Color fundus photograph. 45° field of view. 2184x1690px:
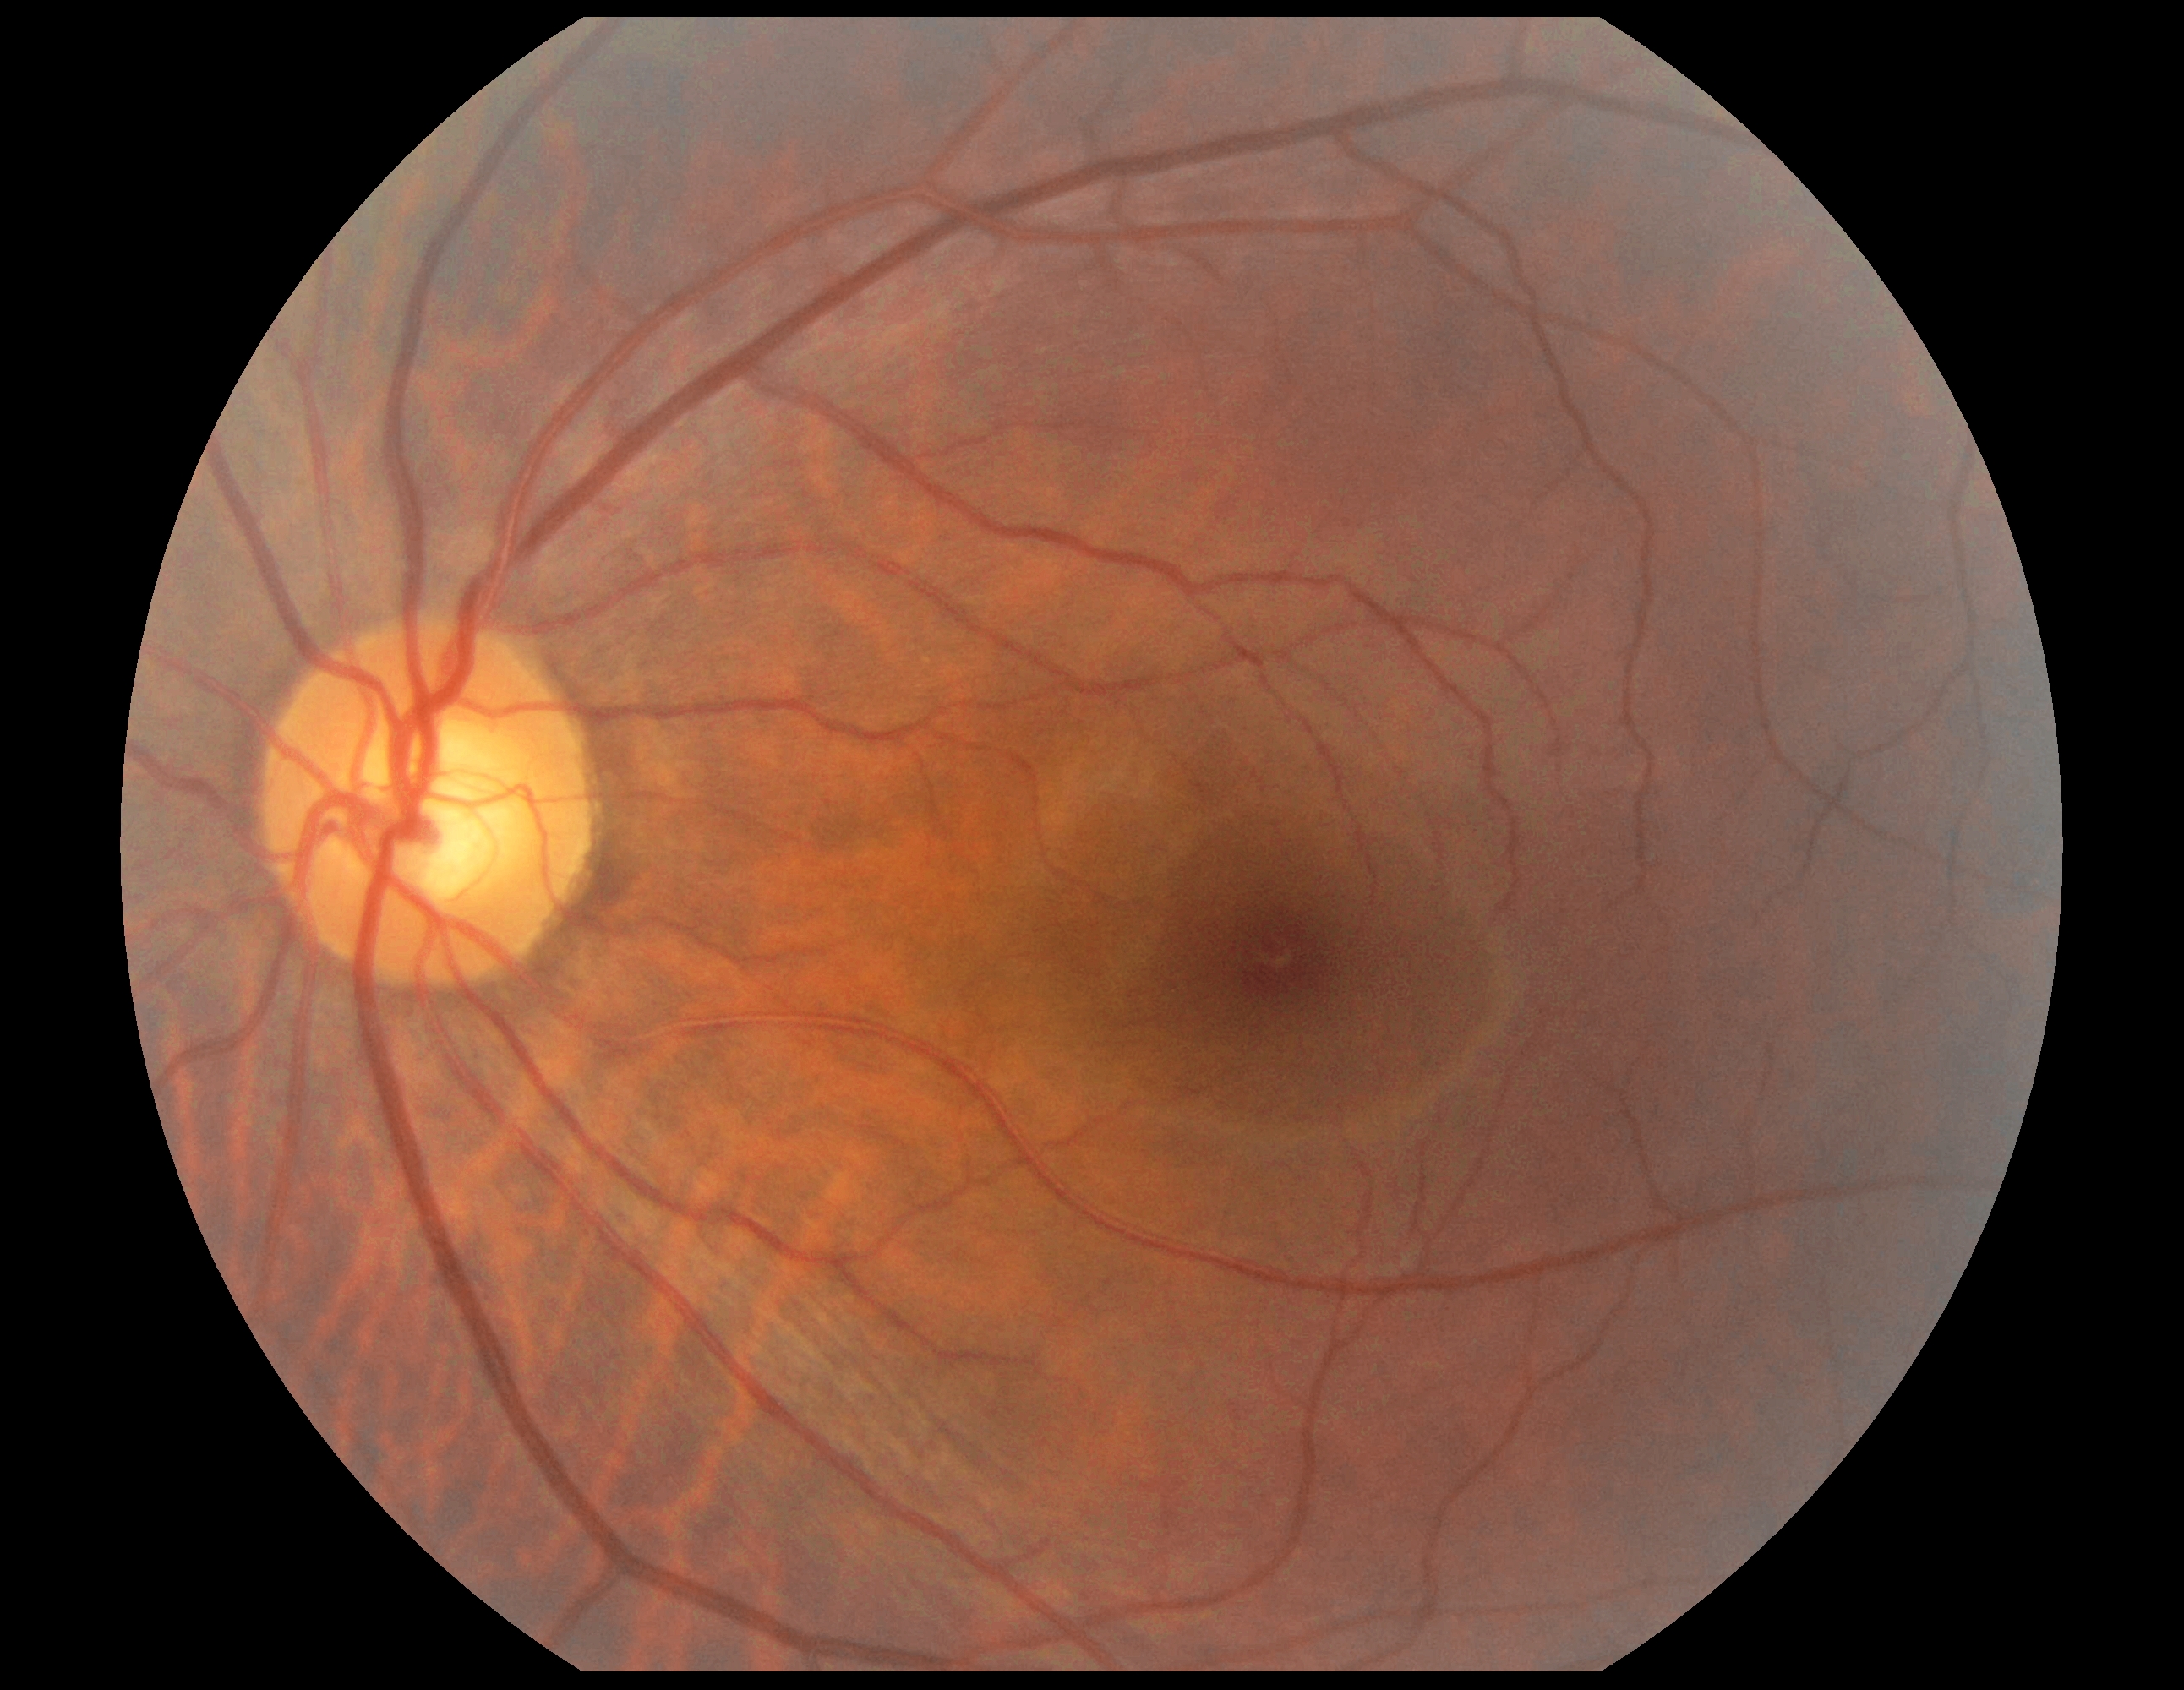

Diabetic retinopathy (DR) is grade 0.